CFP. Without pupil dilation. Graded on the modified Davis scale. 45-degree field of view. Camera: NIDEK AFC-230. 848 by 848 pixels:
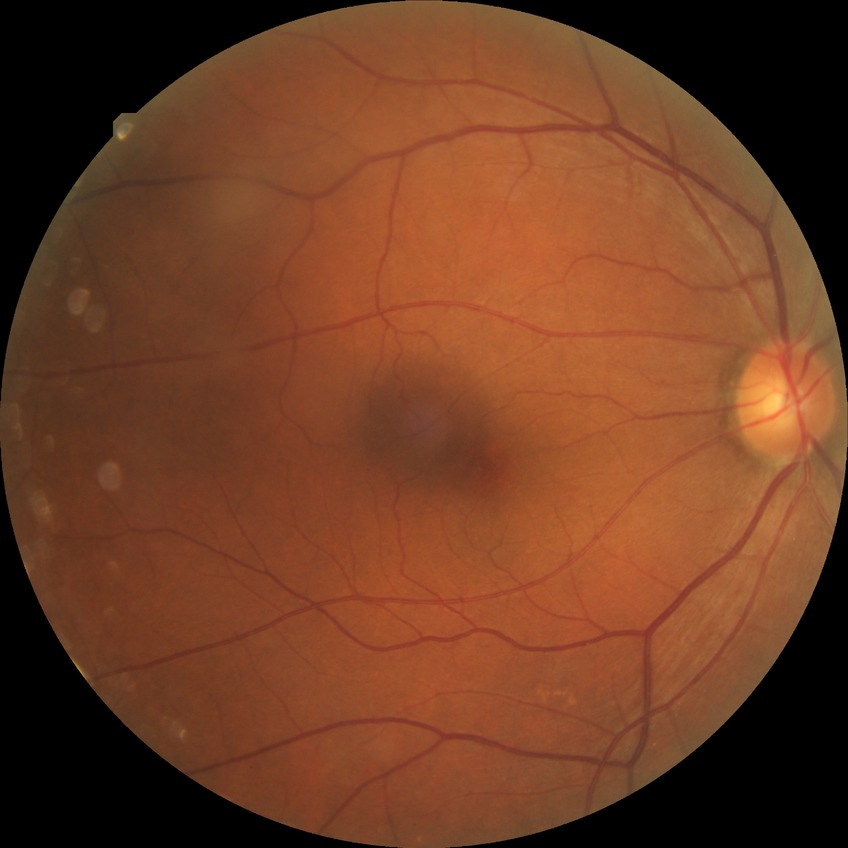 Diabetic retinopathy (DR): PPDR (pre-proliferative diabetic retinopathy).